Fundus photo:
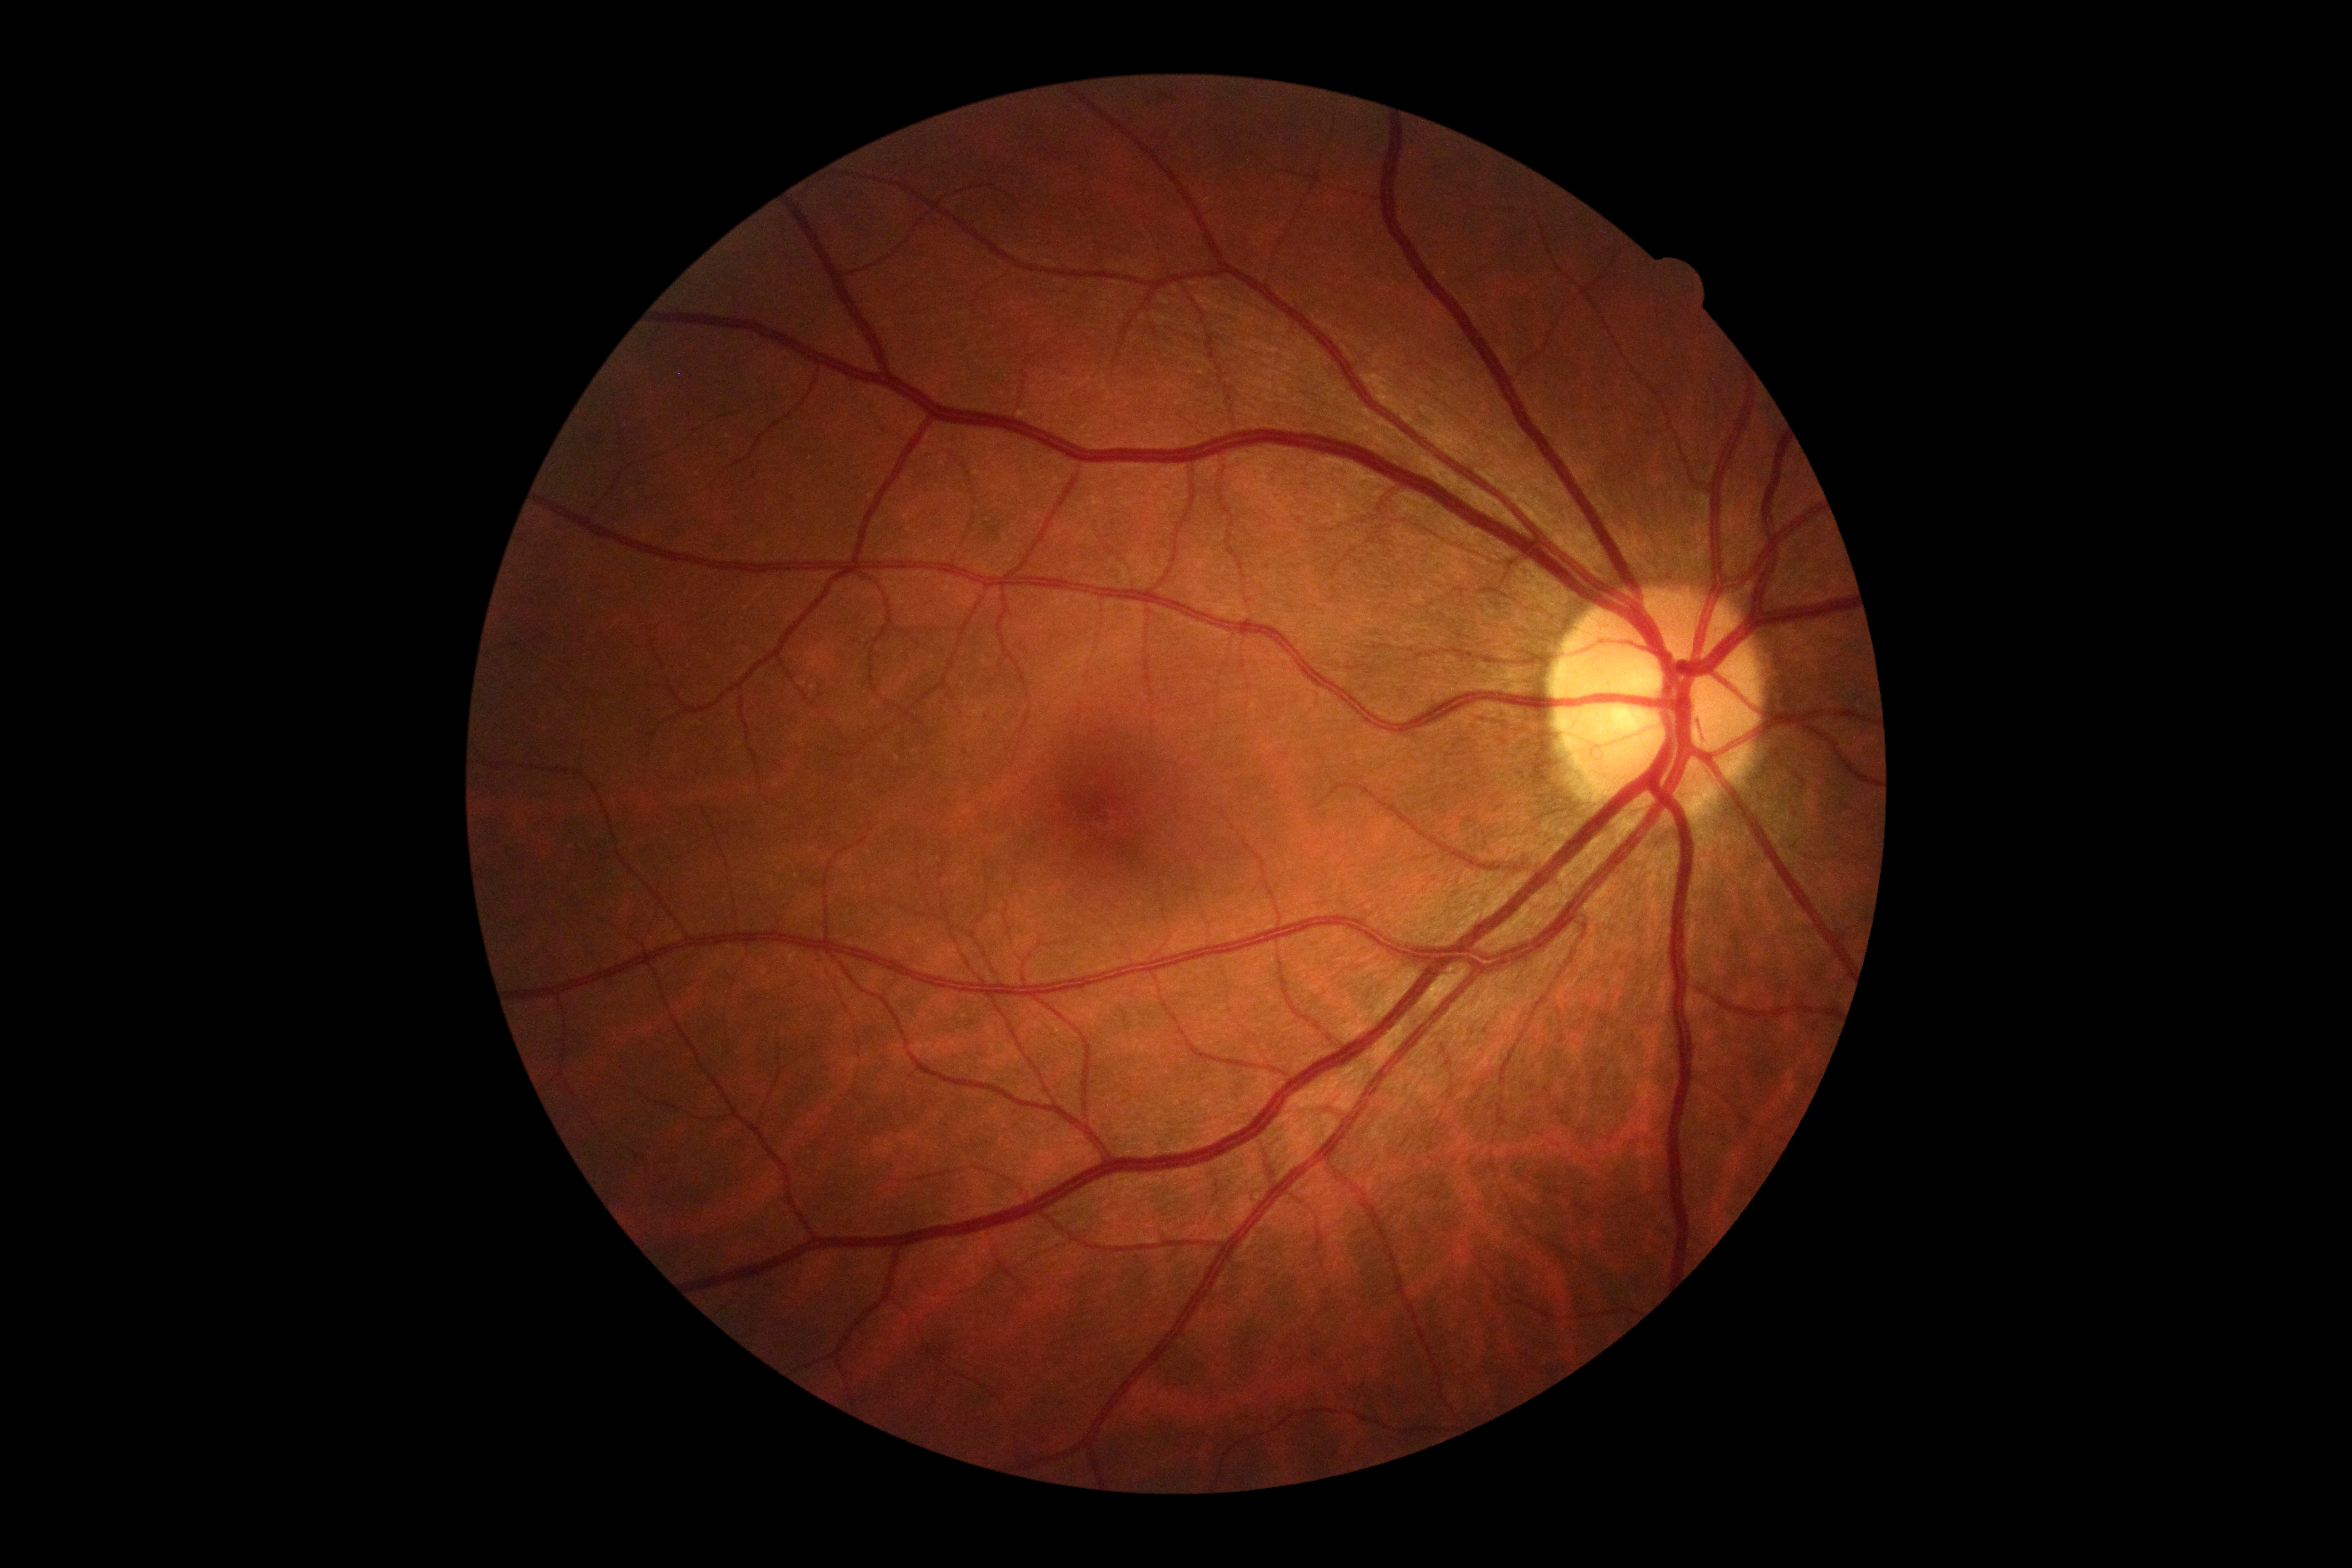 No DR findings. DR stage is 0.